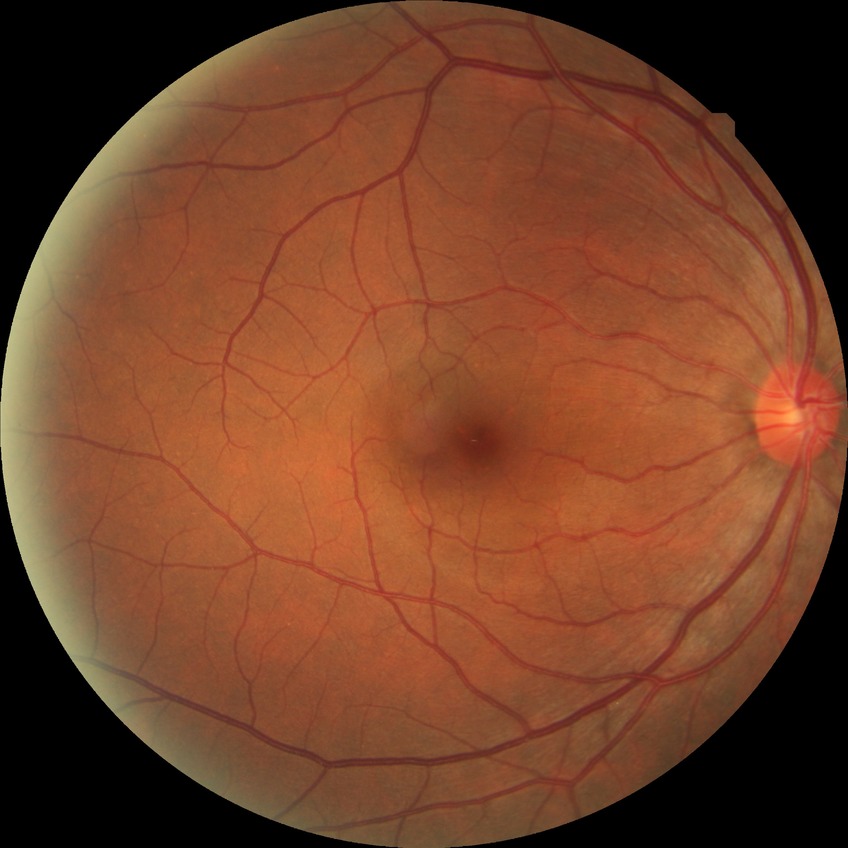

Retinopathy grade: no diabetic retinopathy.